CFP. 1659x2212px. Remidio Fundus on Phone: 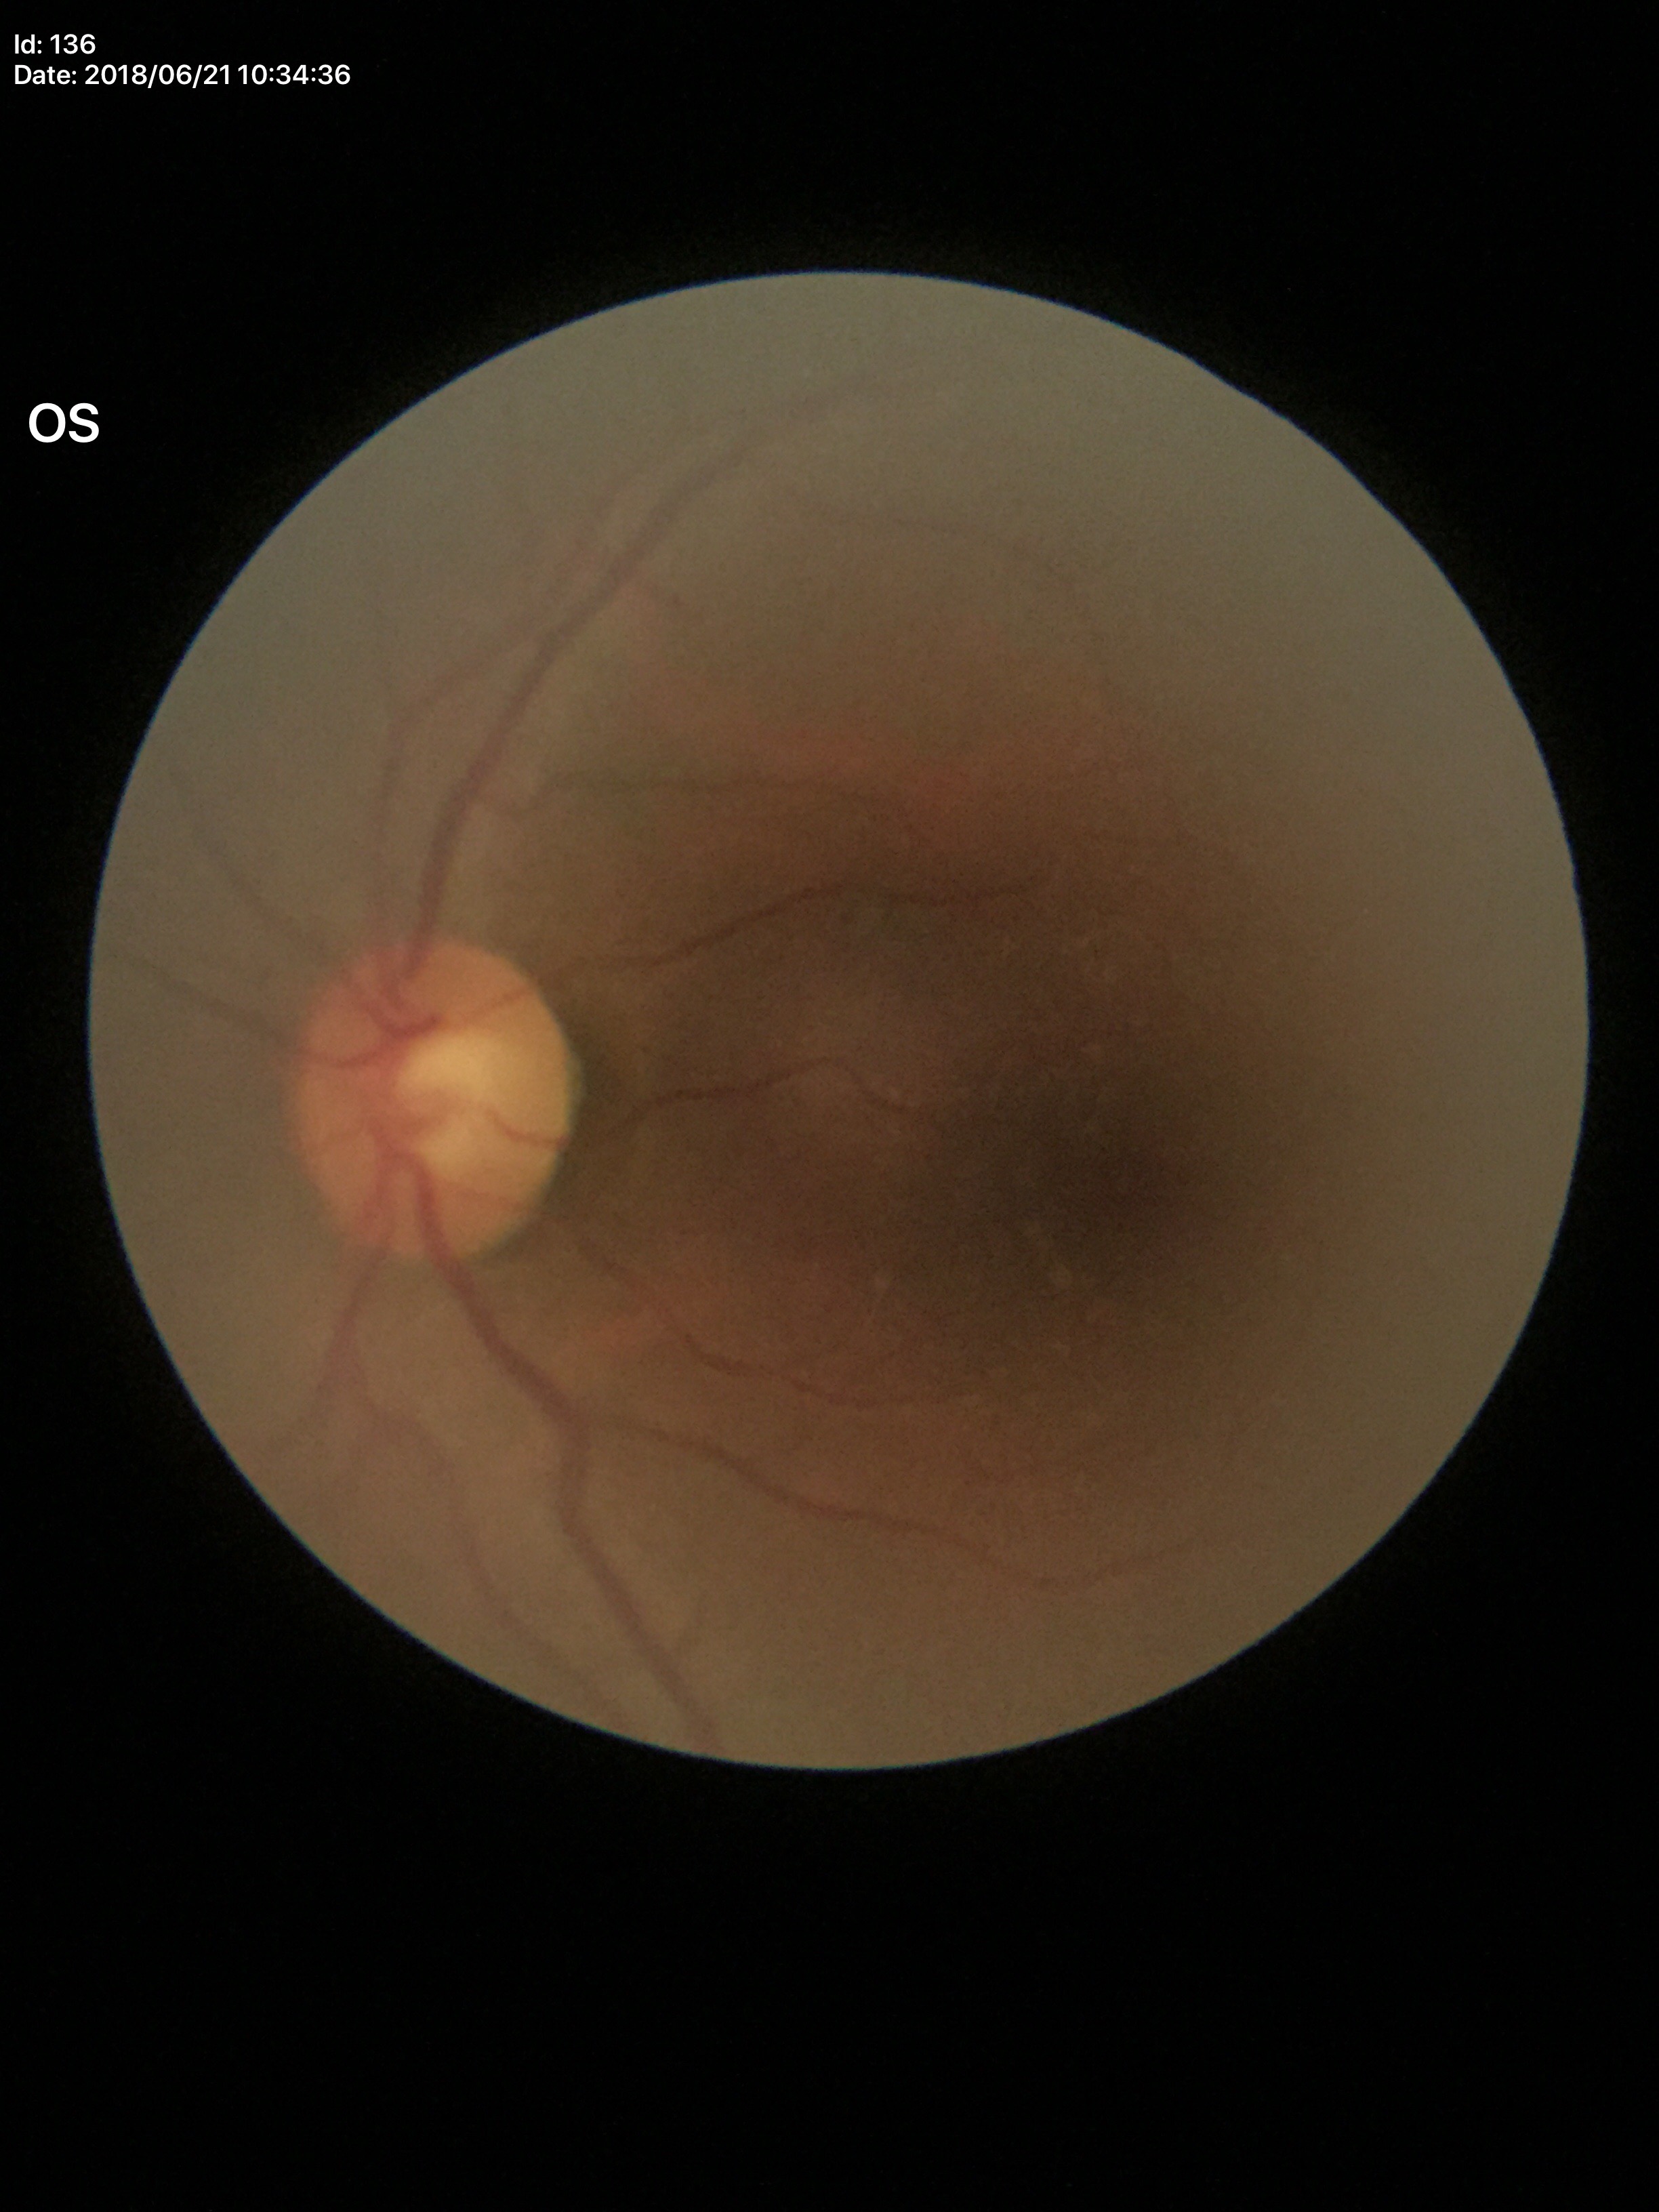

vertical cup-to-disc ratio (VCDR) = 0.52 | Glaucoma assessment = not suspect.